Wide-field contact fundus photograph of an infant · acquired on the Phoenix ICON · 1240x1240px
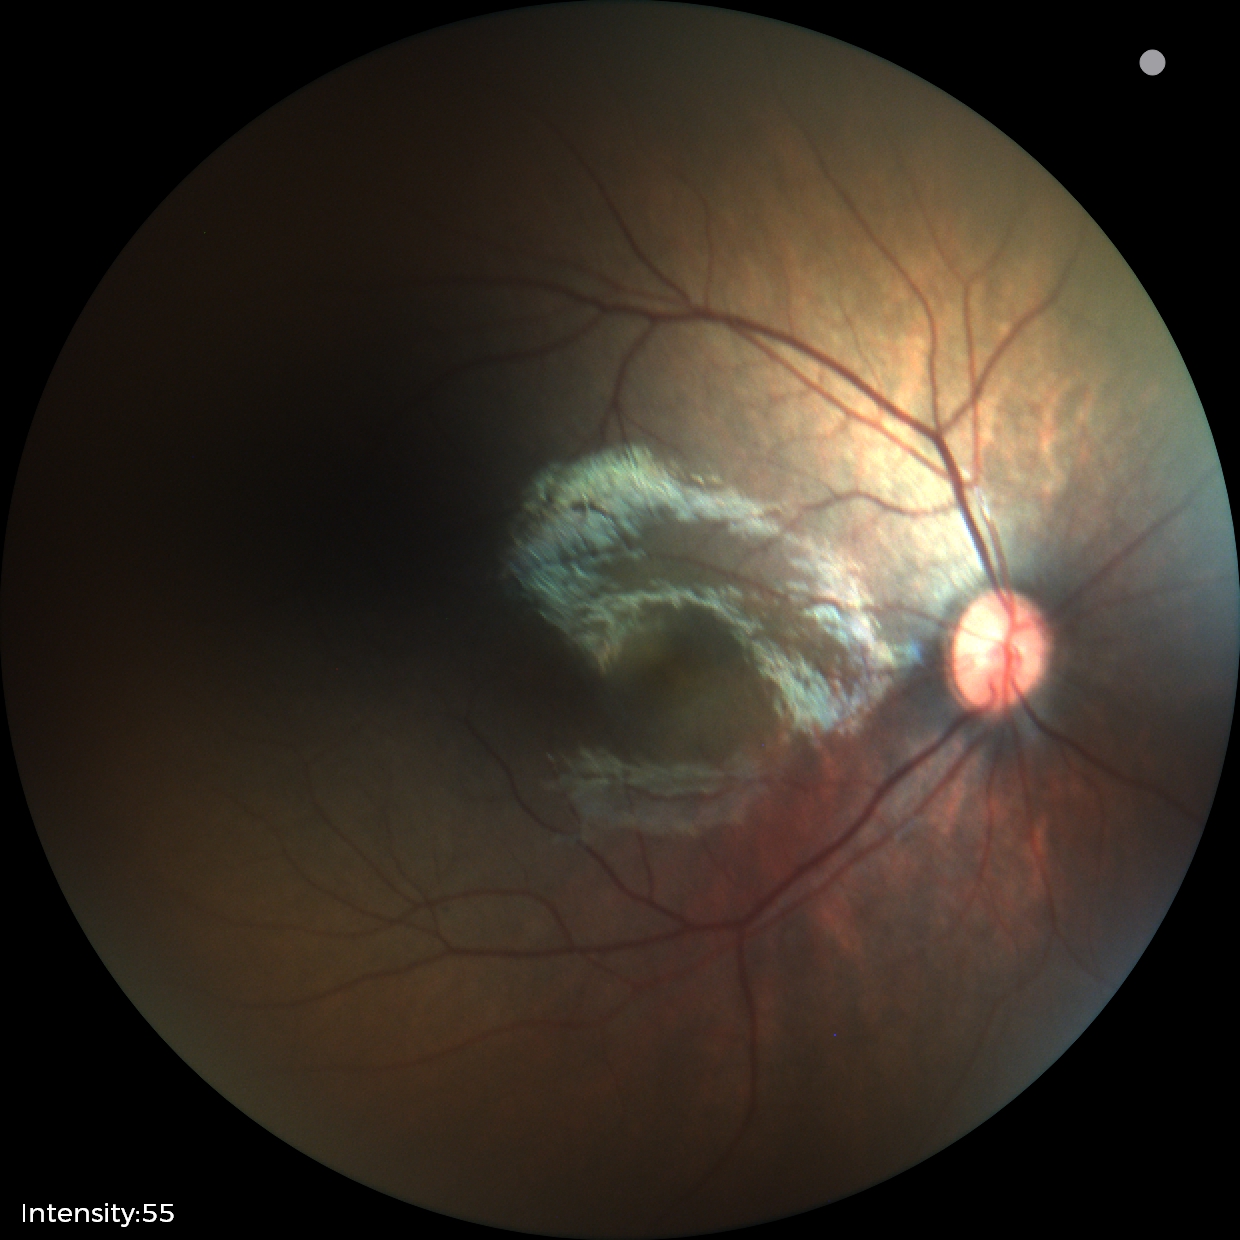 Assessment: physiological finding.